Retinal fundus photograph. Image size 1659x2212. Acquired with a Remidio Fundus on Phone.
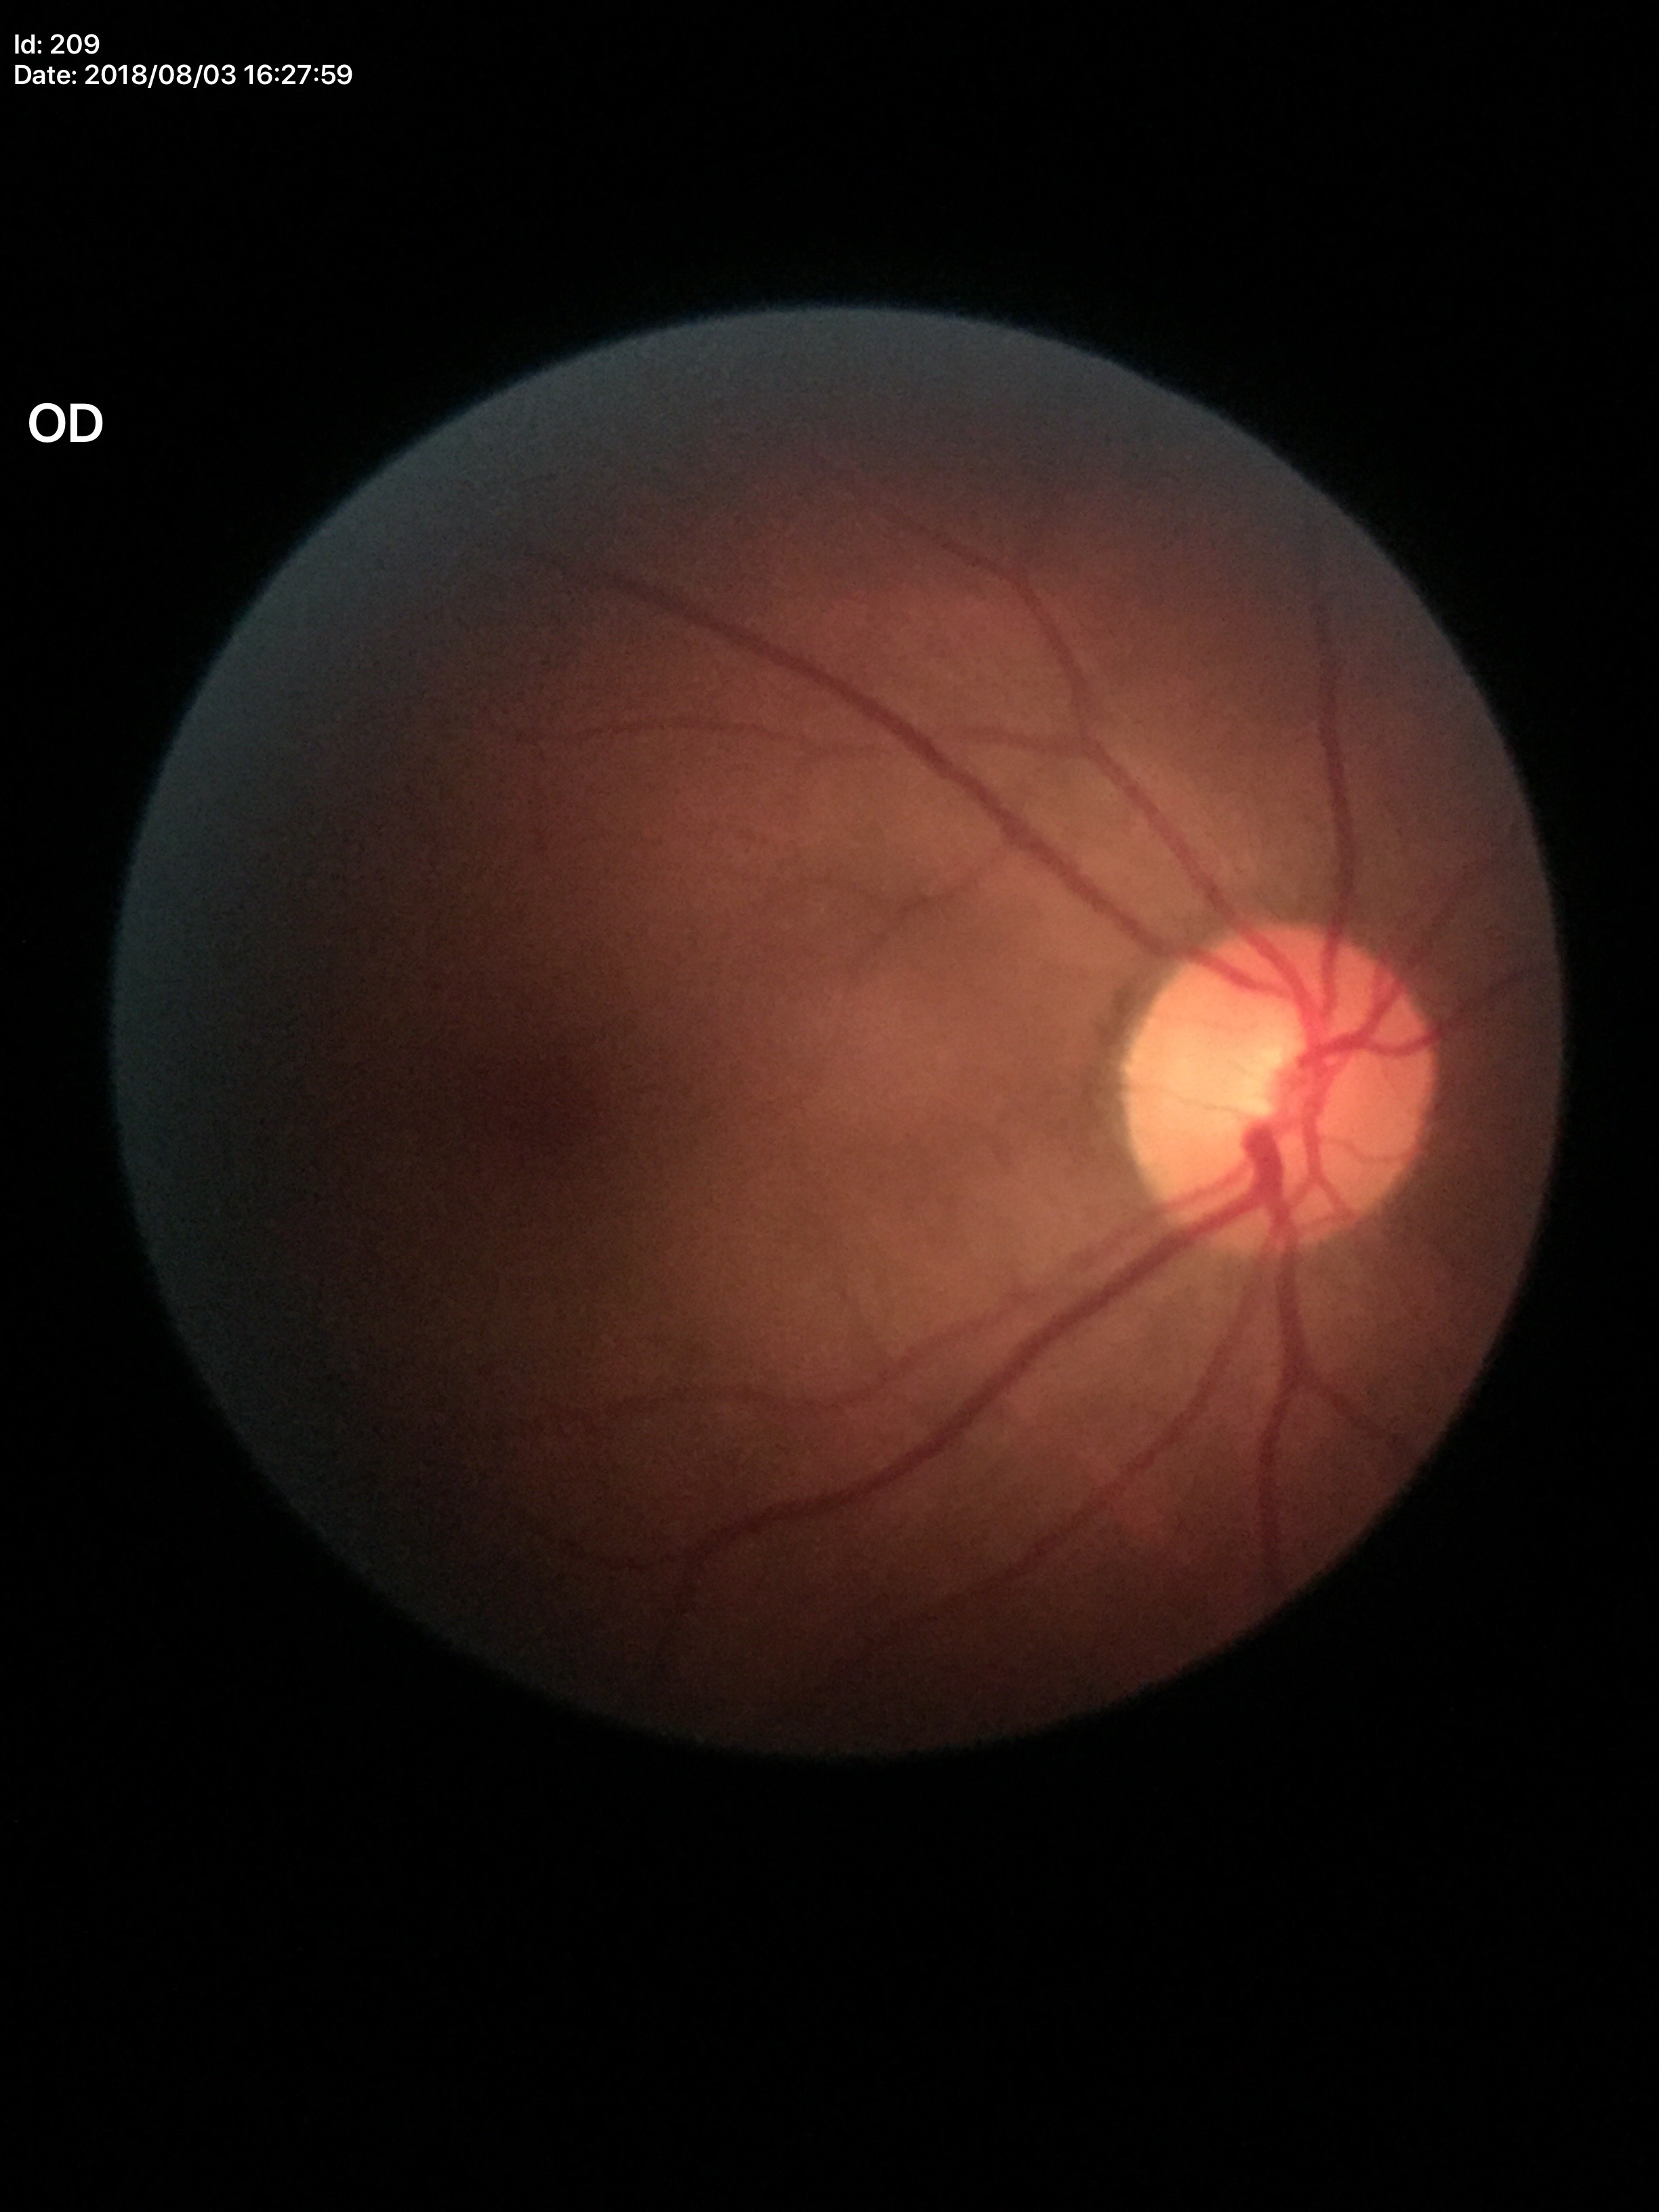
Glaucoma decision: not suspect | vertical cup-to-disc ratio: 0.43 | horizontal cup-to-disc ratio: 0.41.